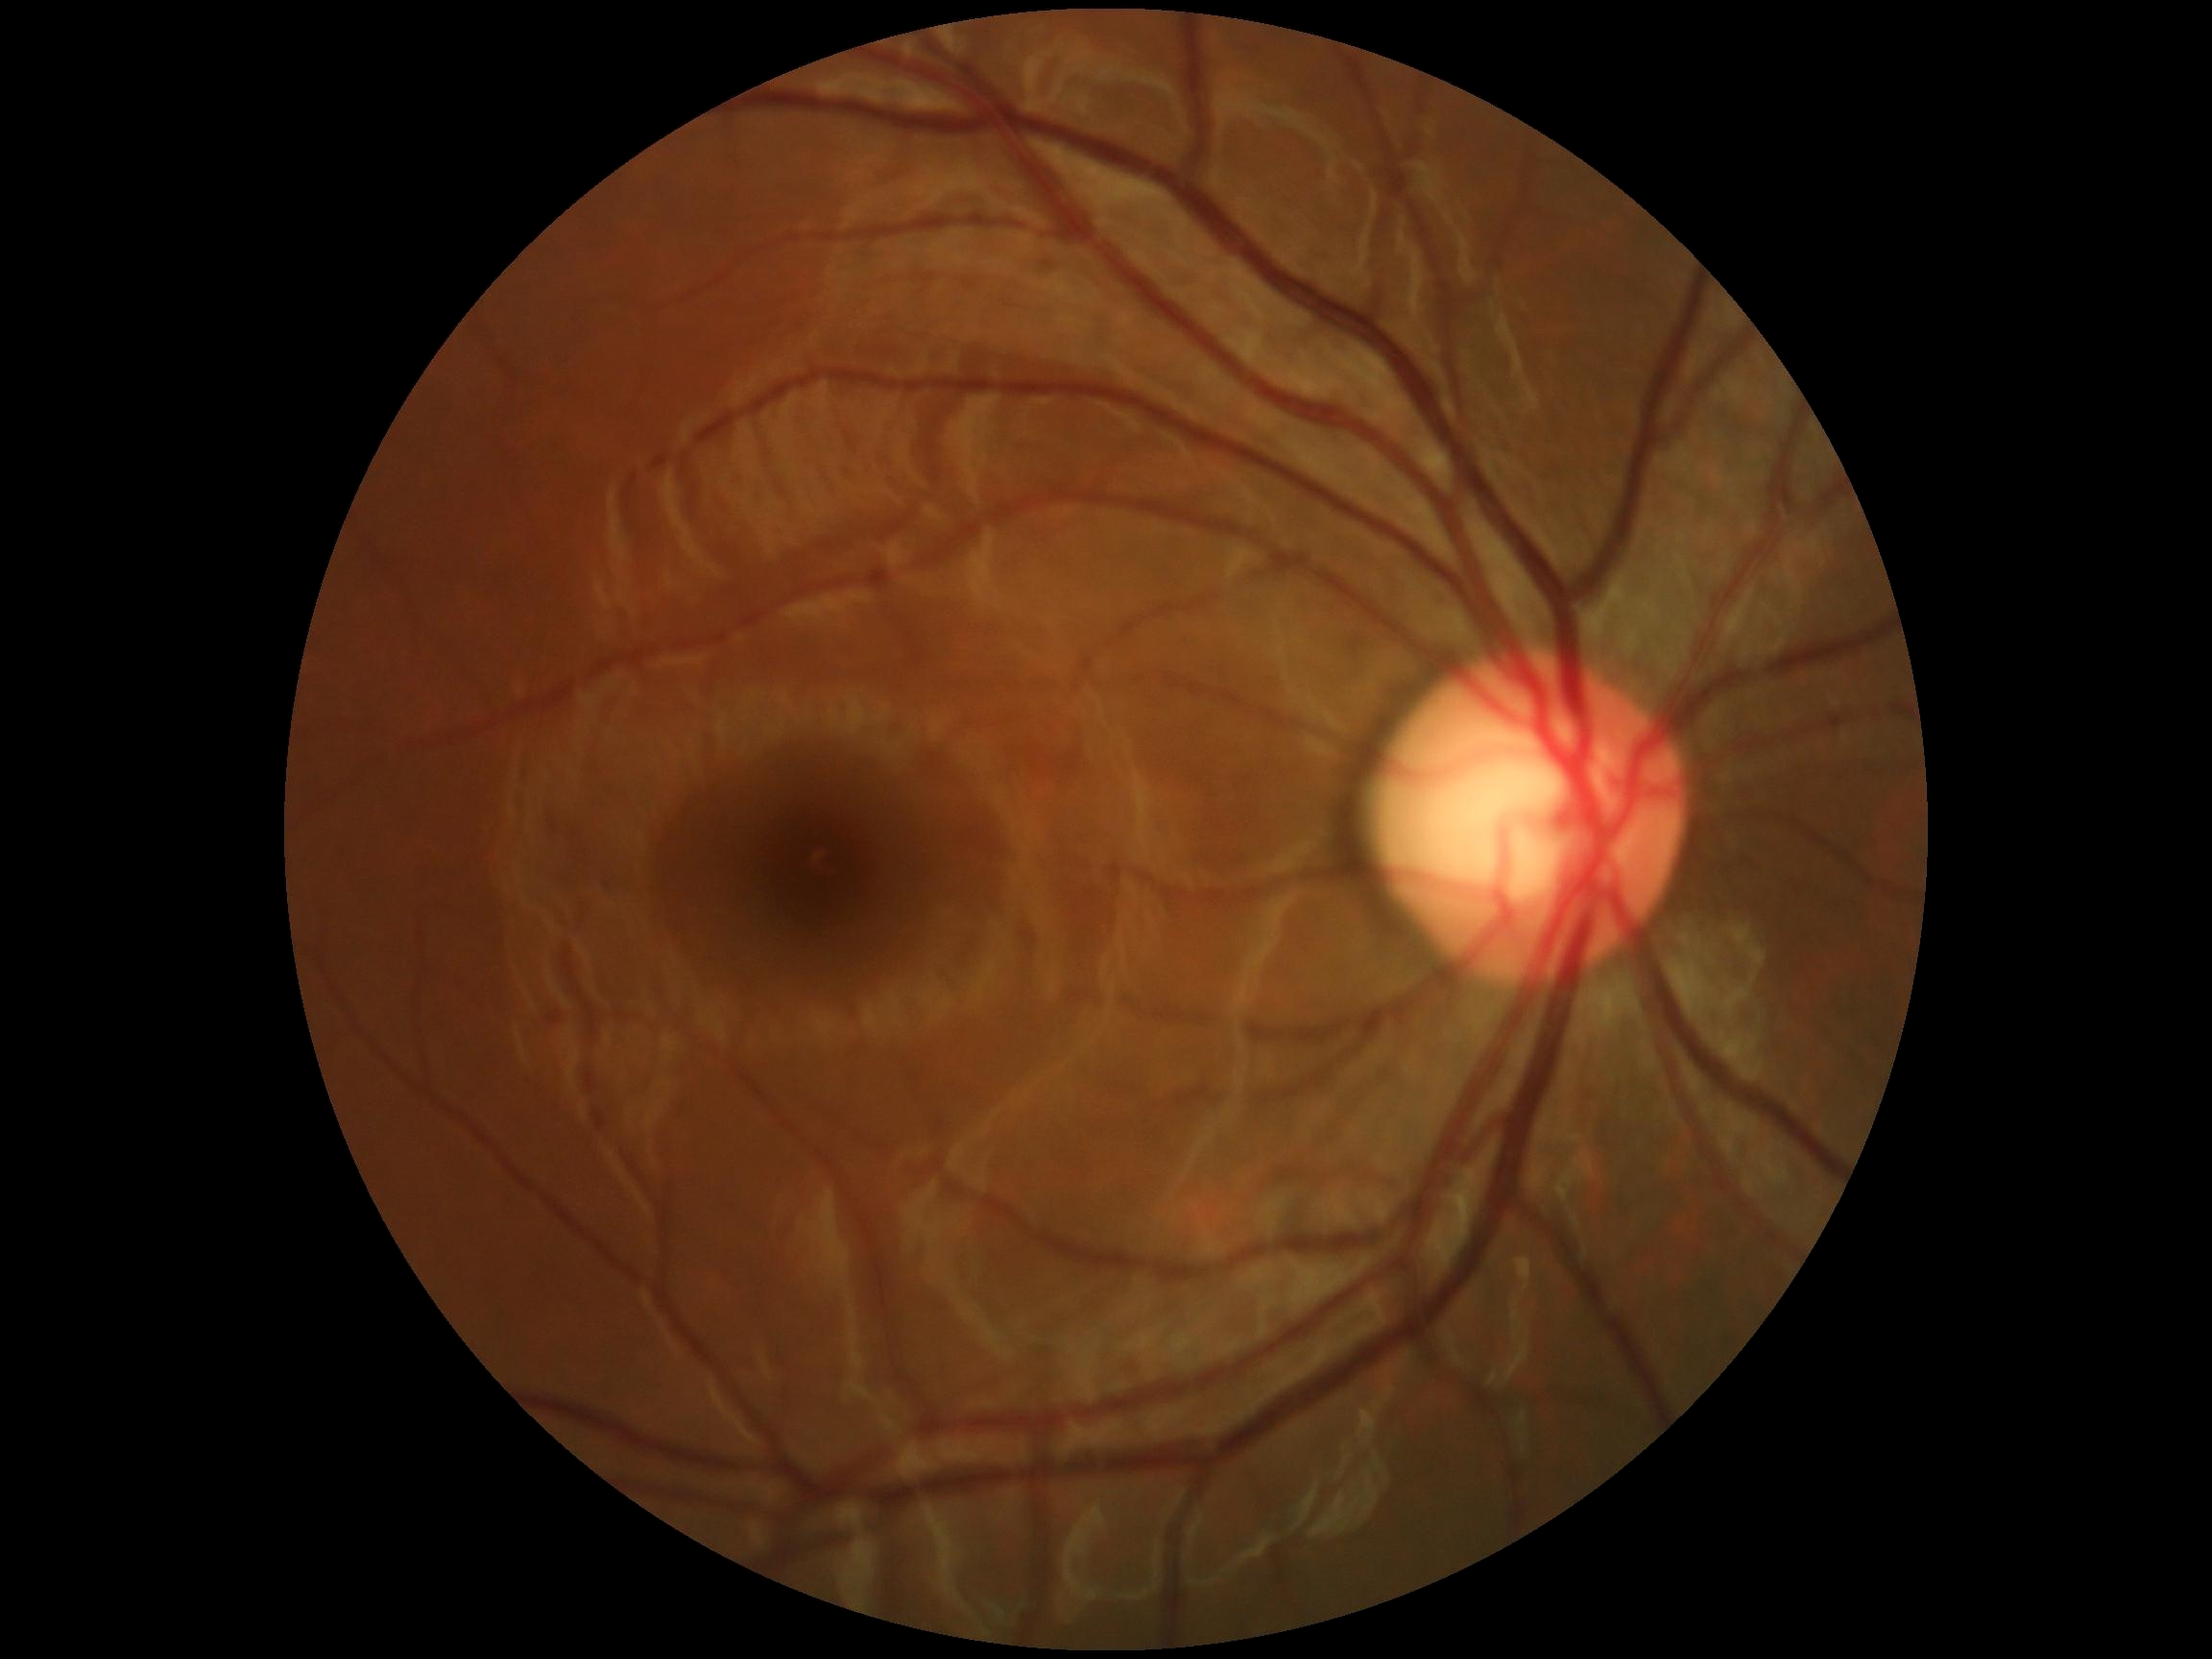

DR stage: grade 0 — no visible signs of diabetic retinopathy.